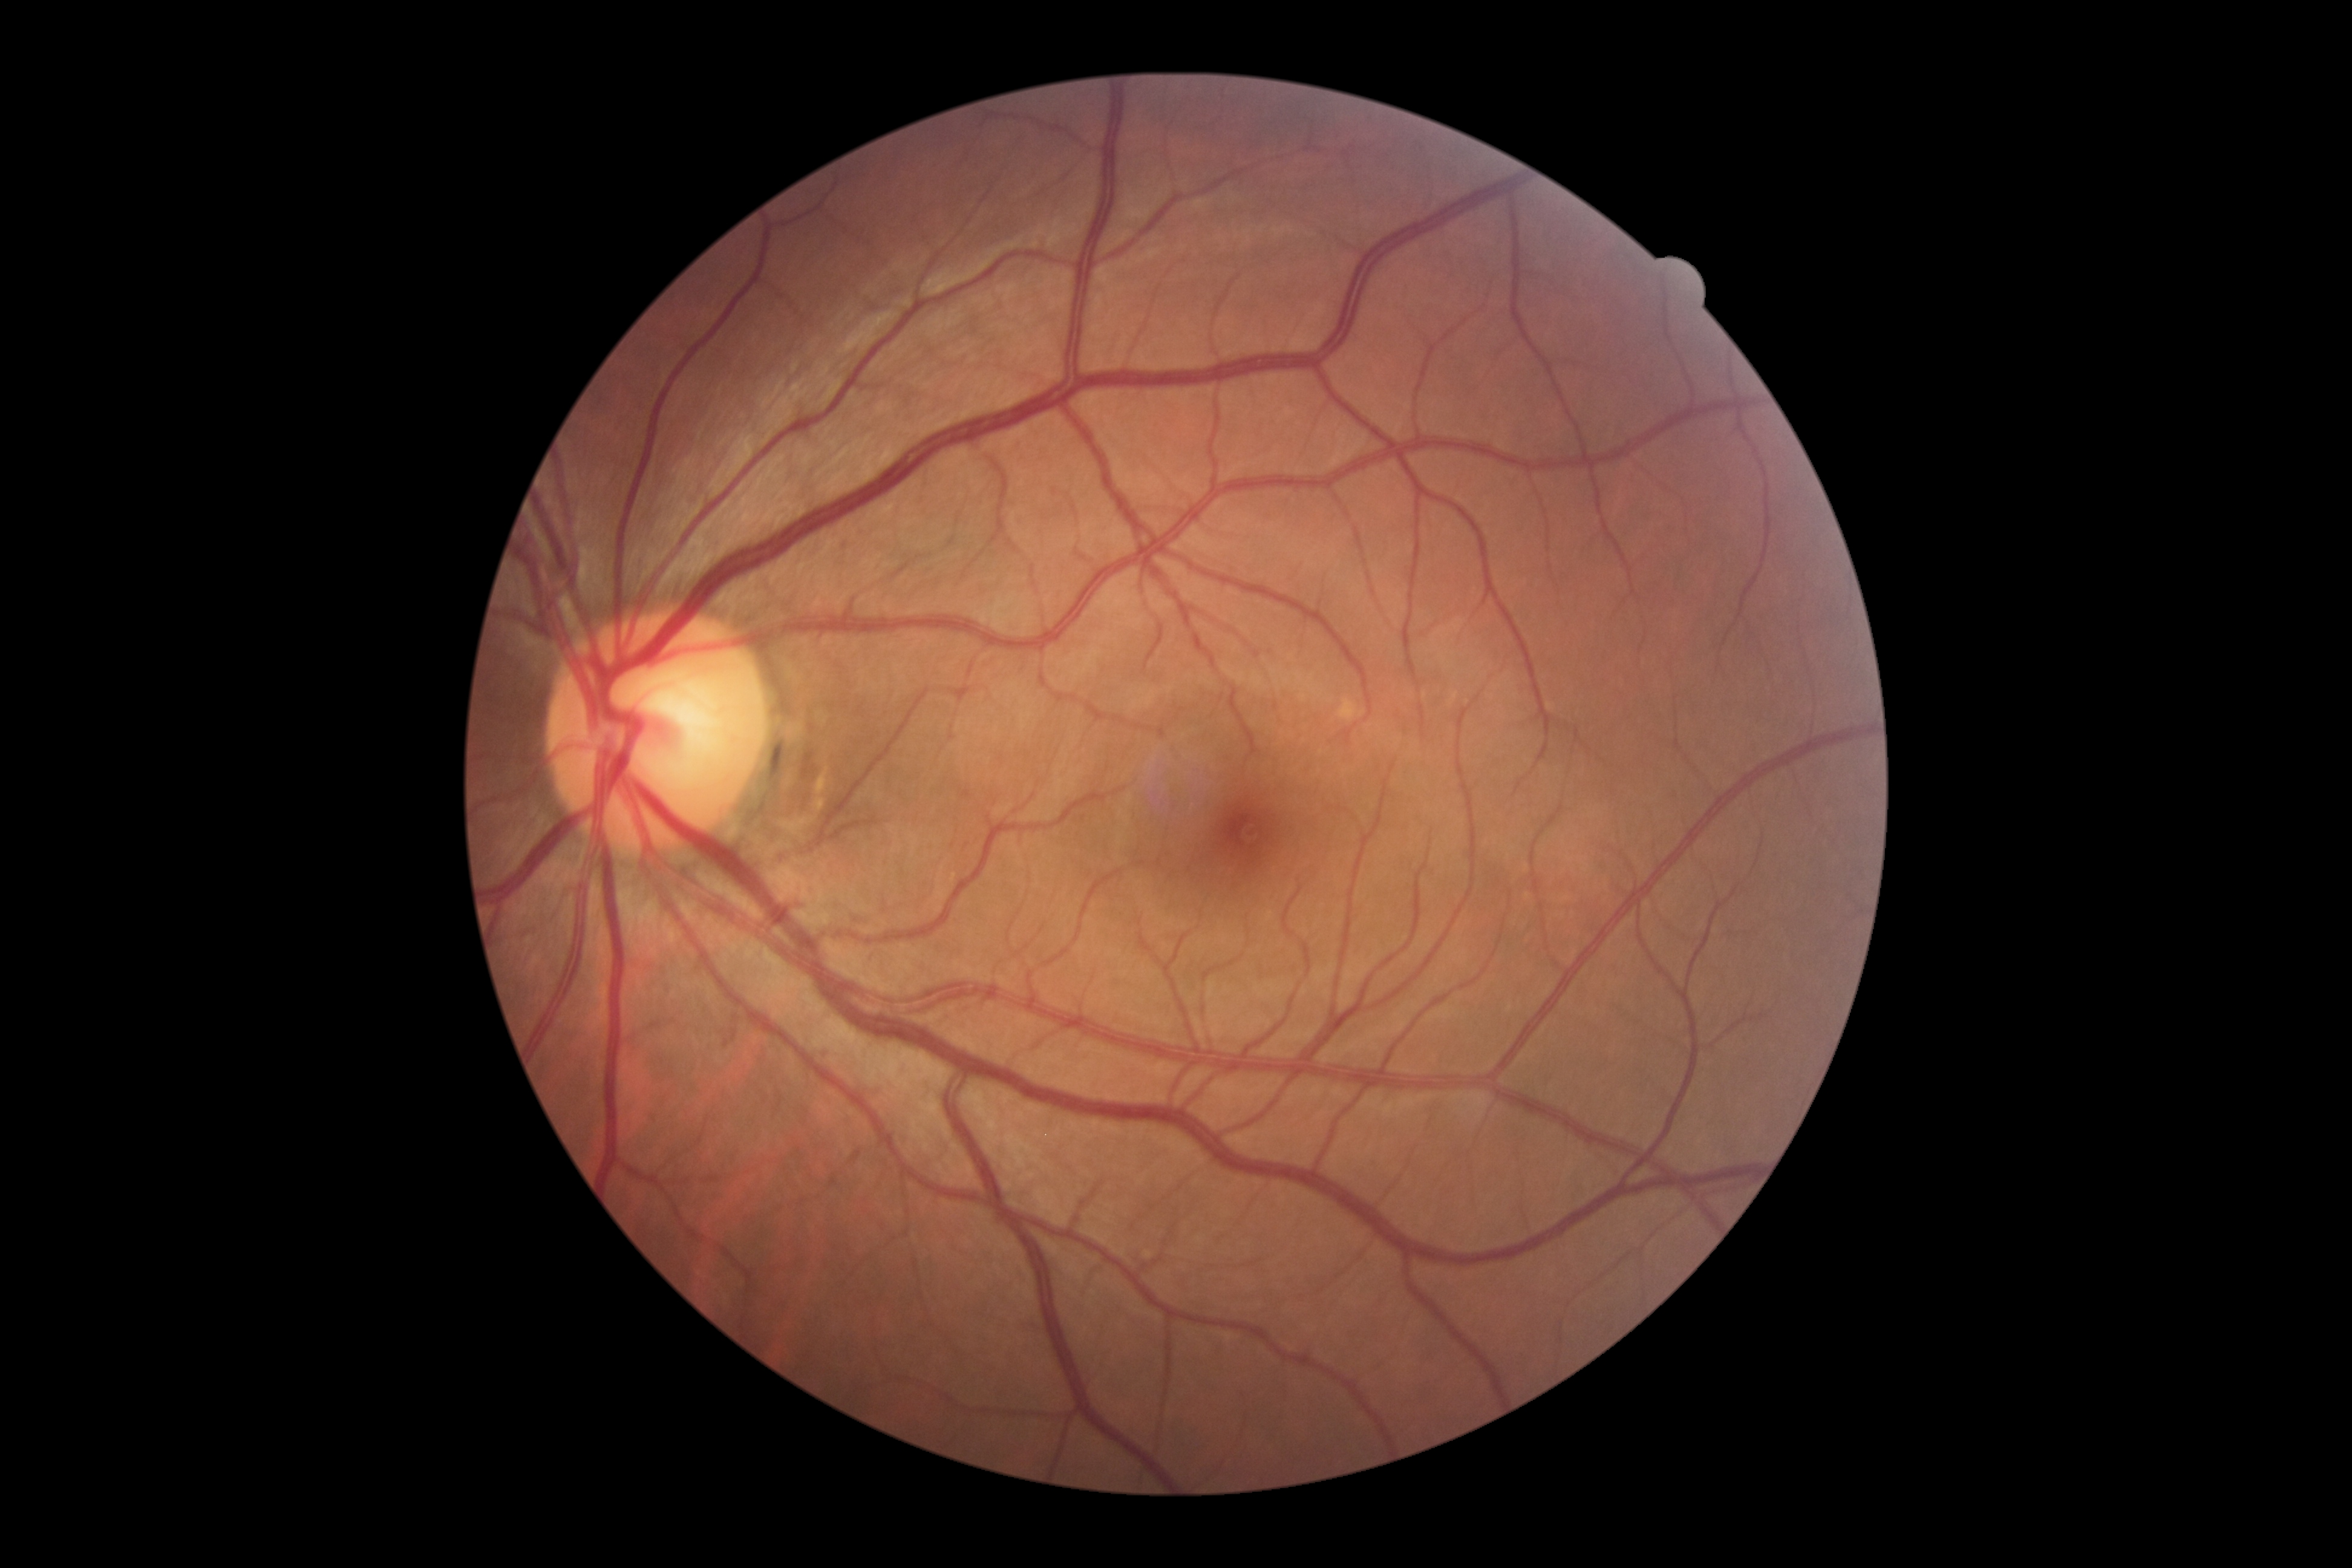 DR impression=no signs of DR; diabetic retinopathy grade=0 (no apparent retinopathy).